Optic nerve head photograph:
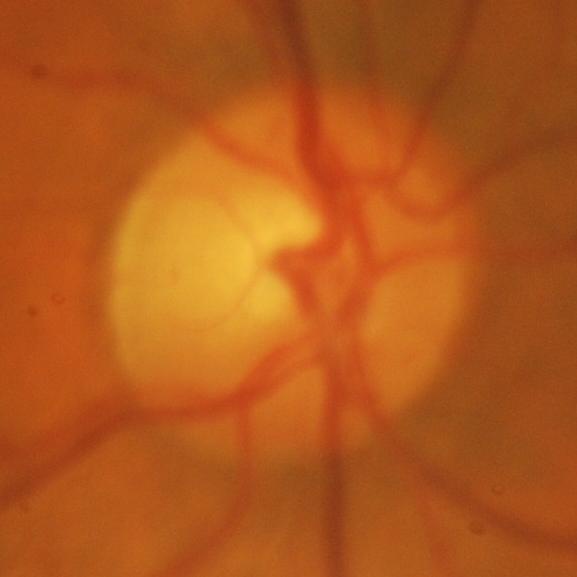
Q: Is there glaucomatous optic neuropathy?
A: Glaucomatous damage to the optic nerve.